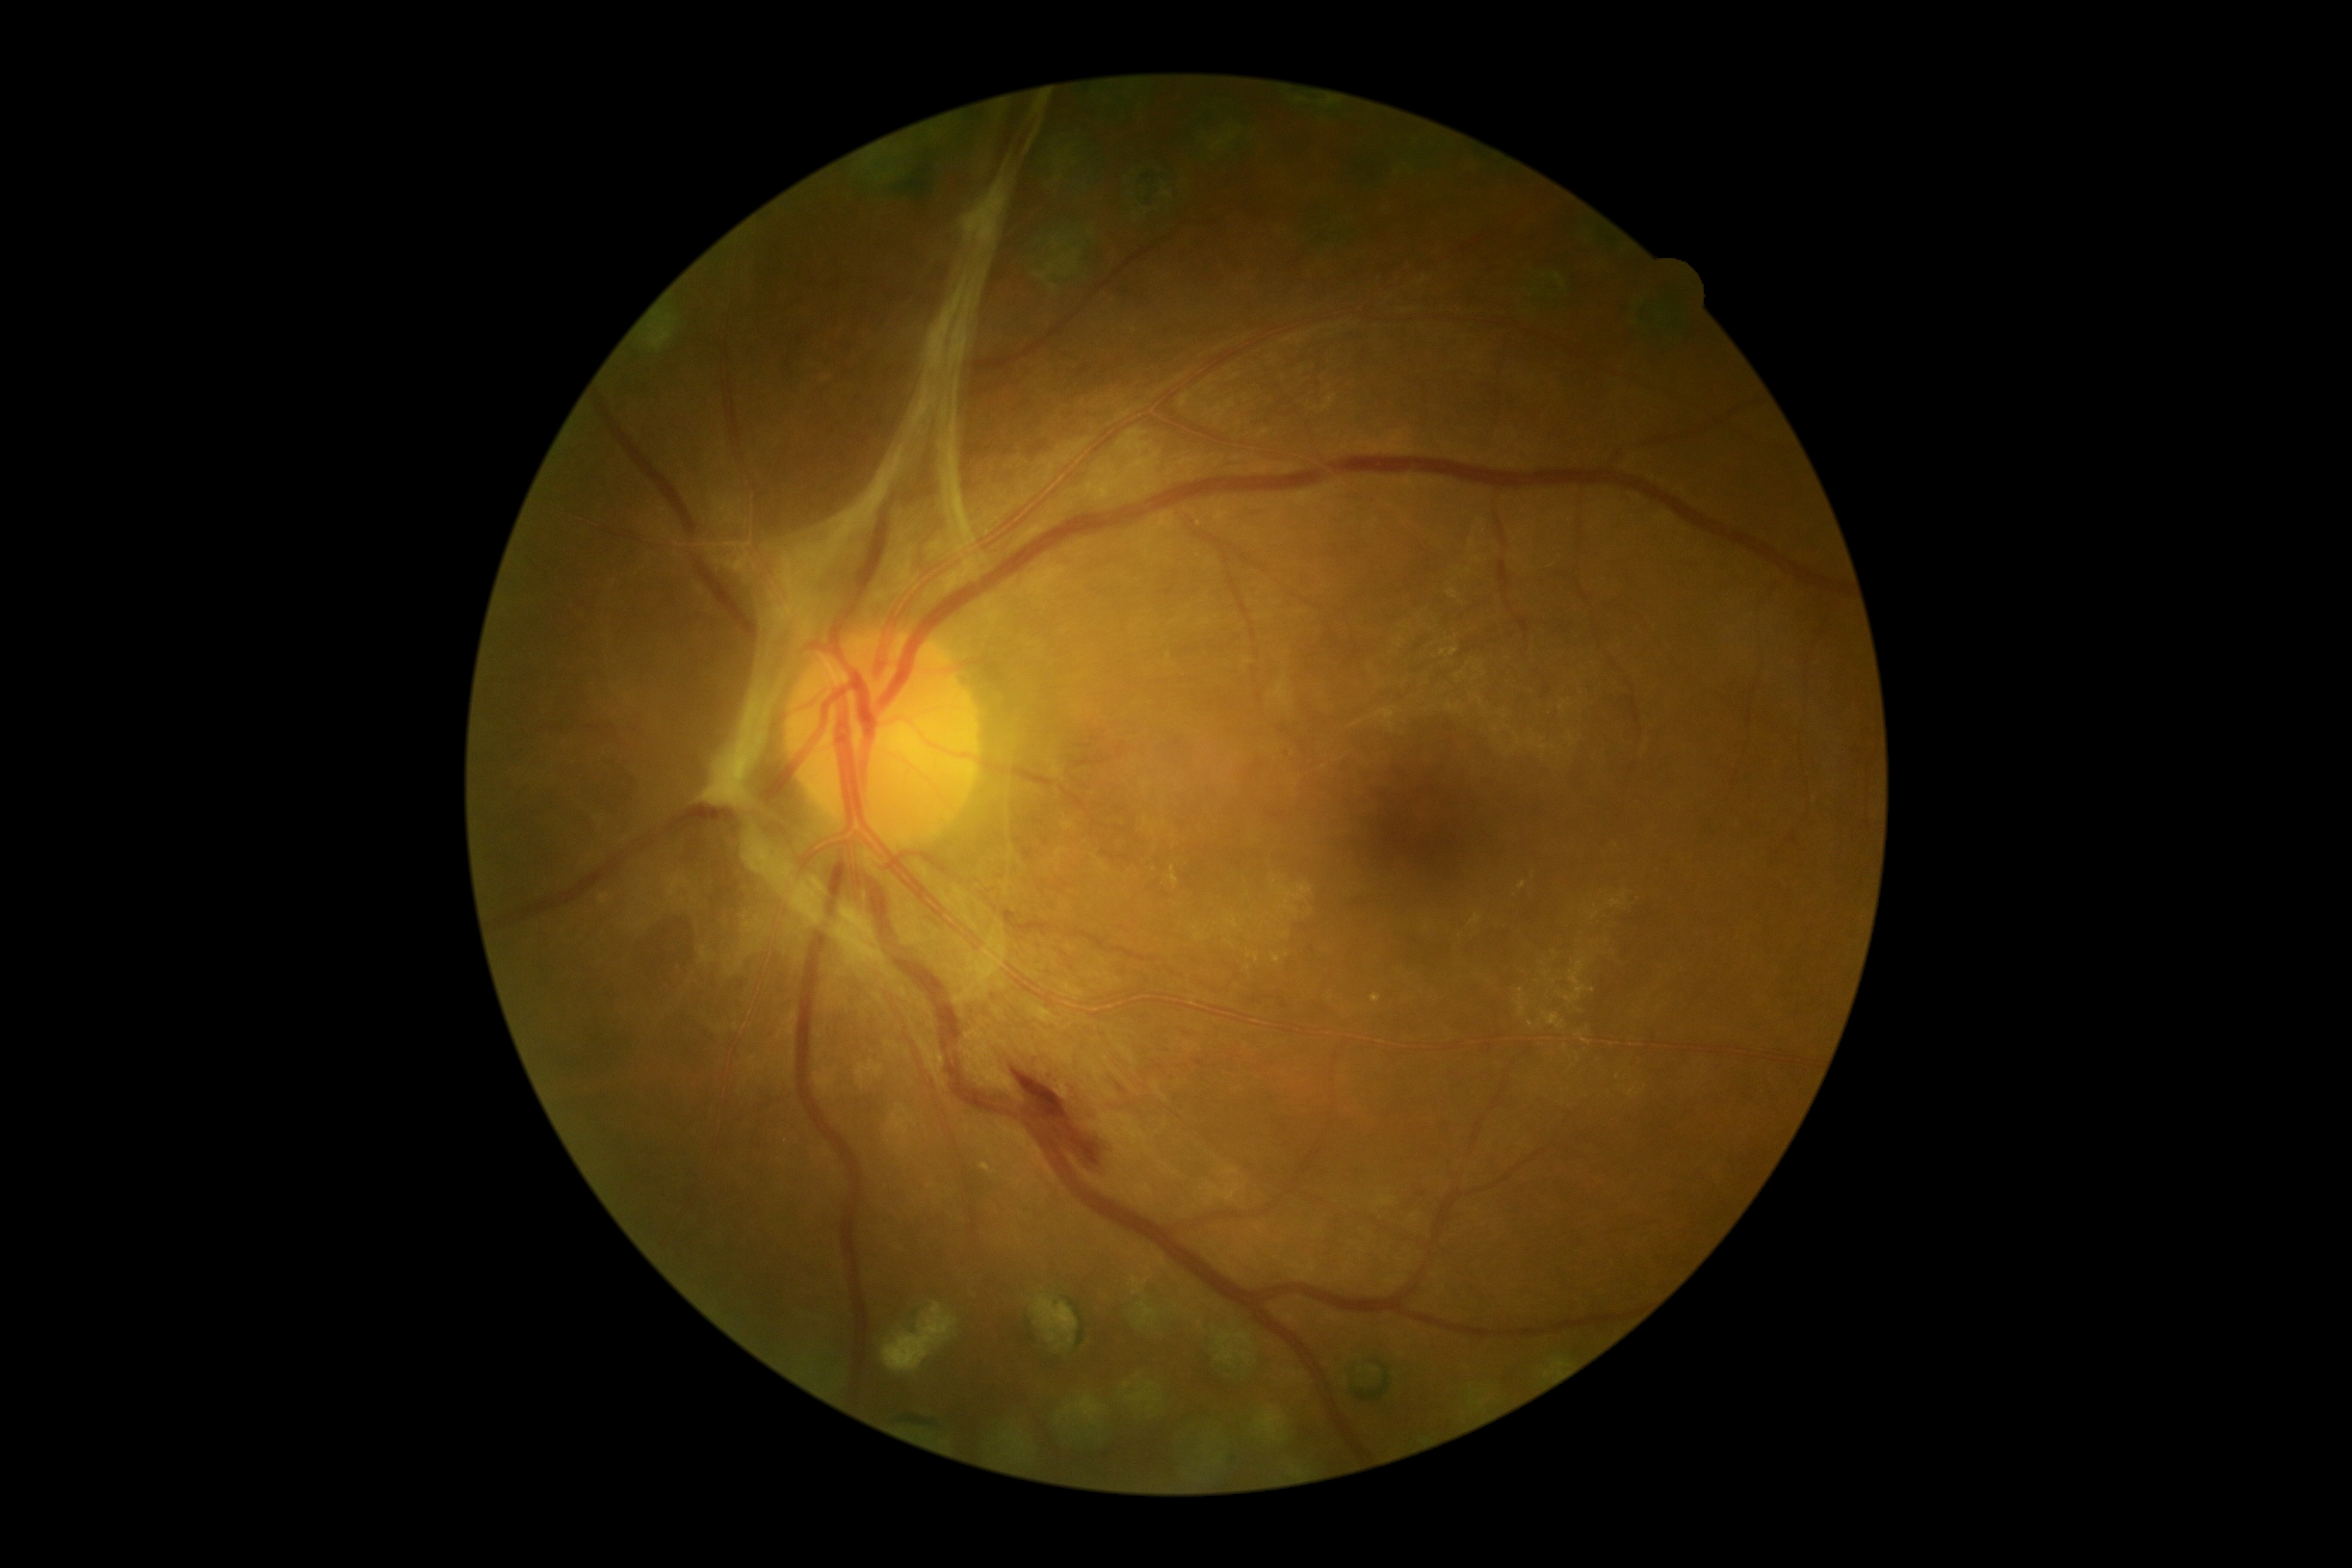

Findings:
* DR grade — PDR (4) — neovascularization and/or vitreous/pre-retinal hemorrhage